45-degree field of view · 1920 by 1088 pixels · fundus photo: 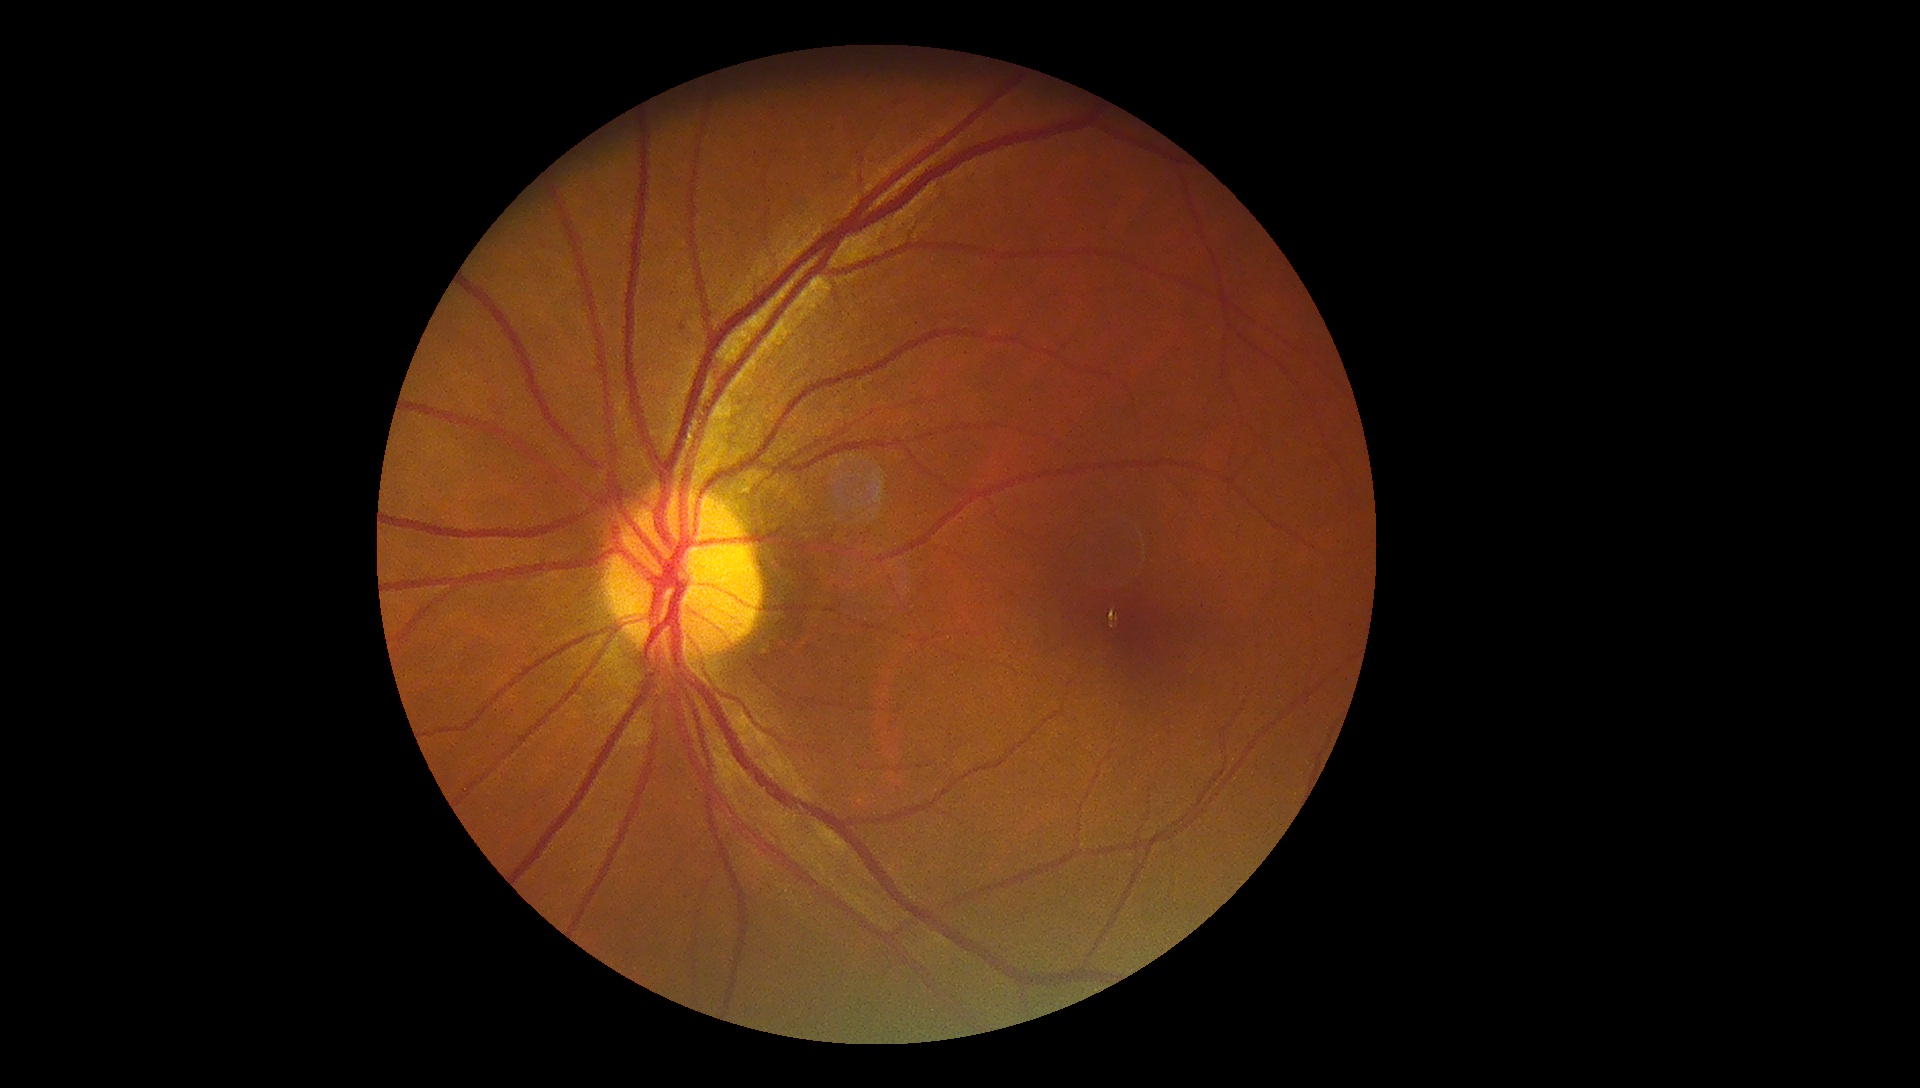 Diabetic retinopathy (DR) is grade 1 (mild NPDR).